Davis DR grading, nonmydriatic
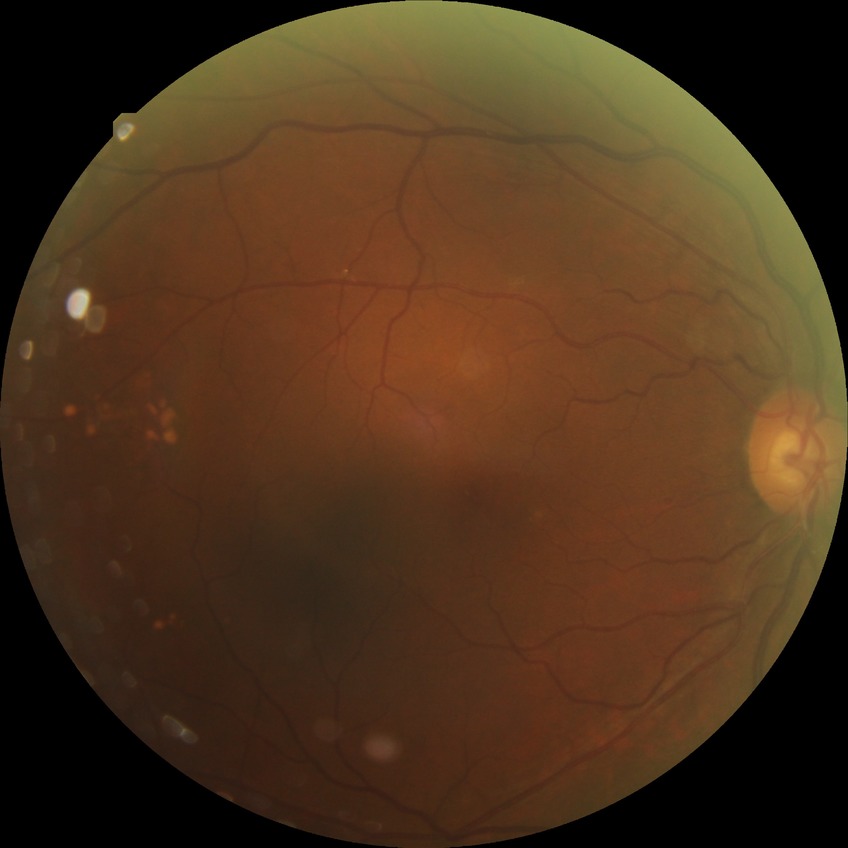
Diabetic retinopathy stage is no diabetic retinopathy.